2212 by 1659 pixels:
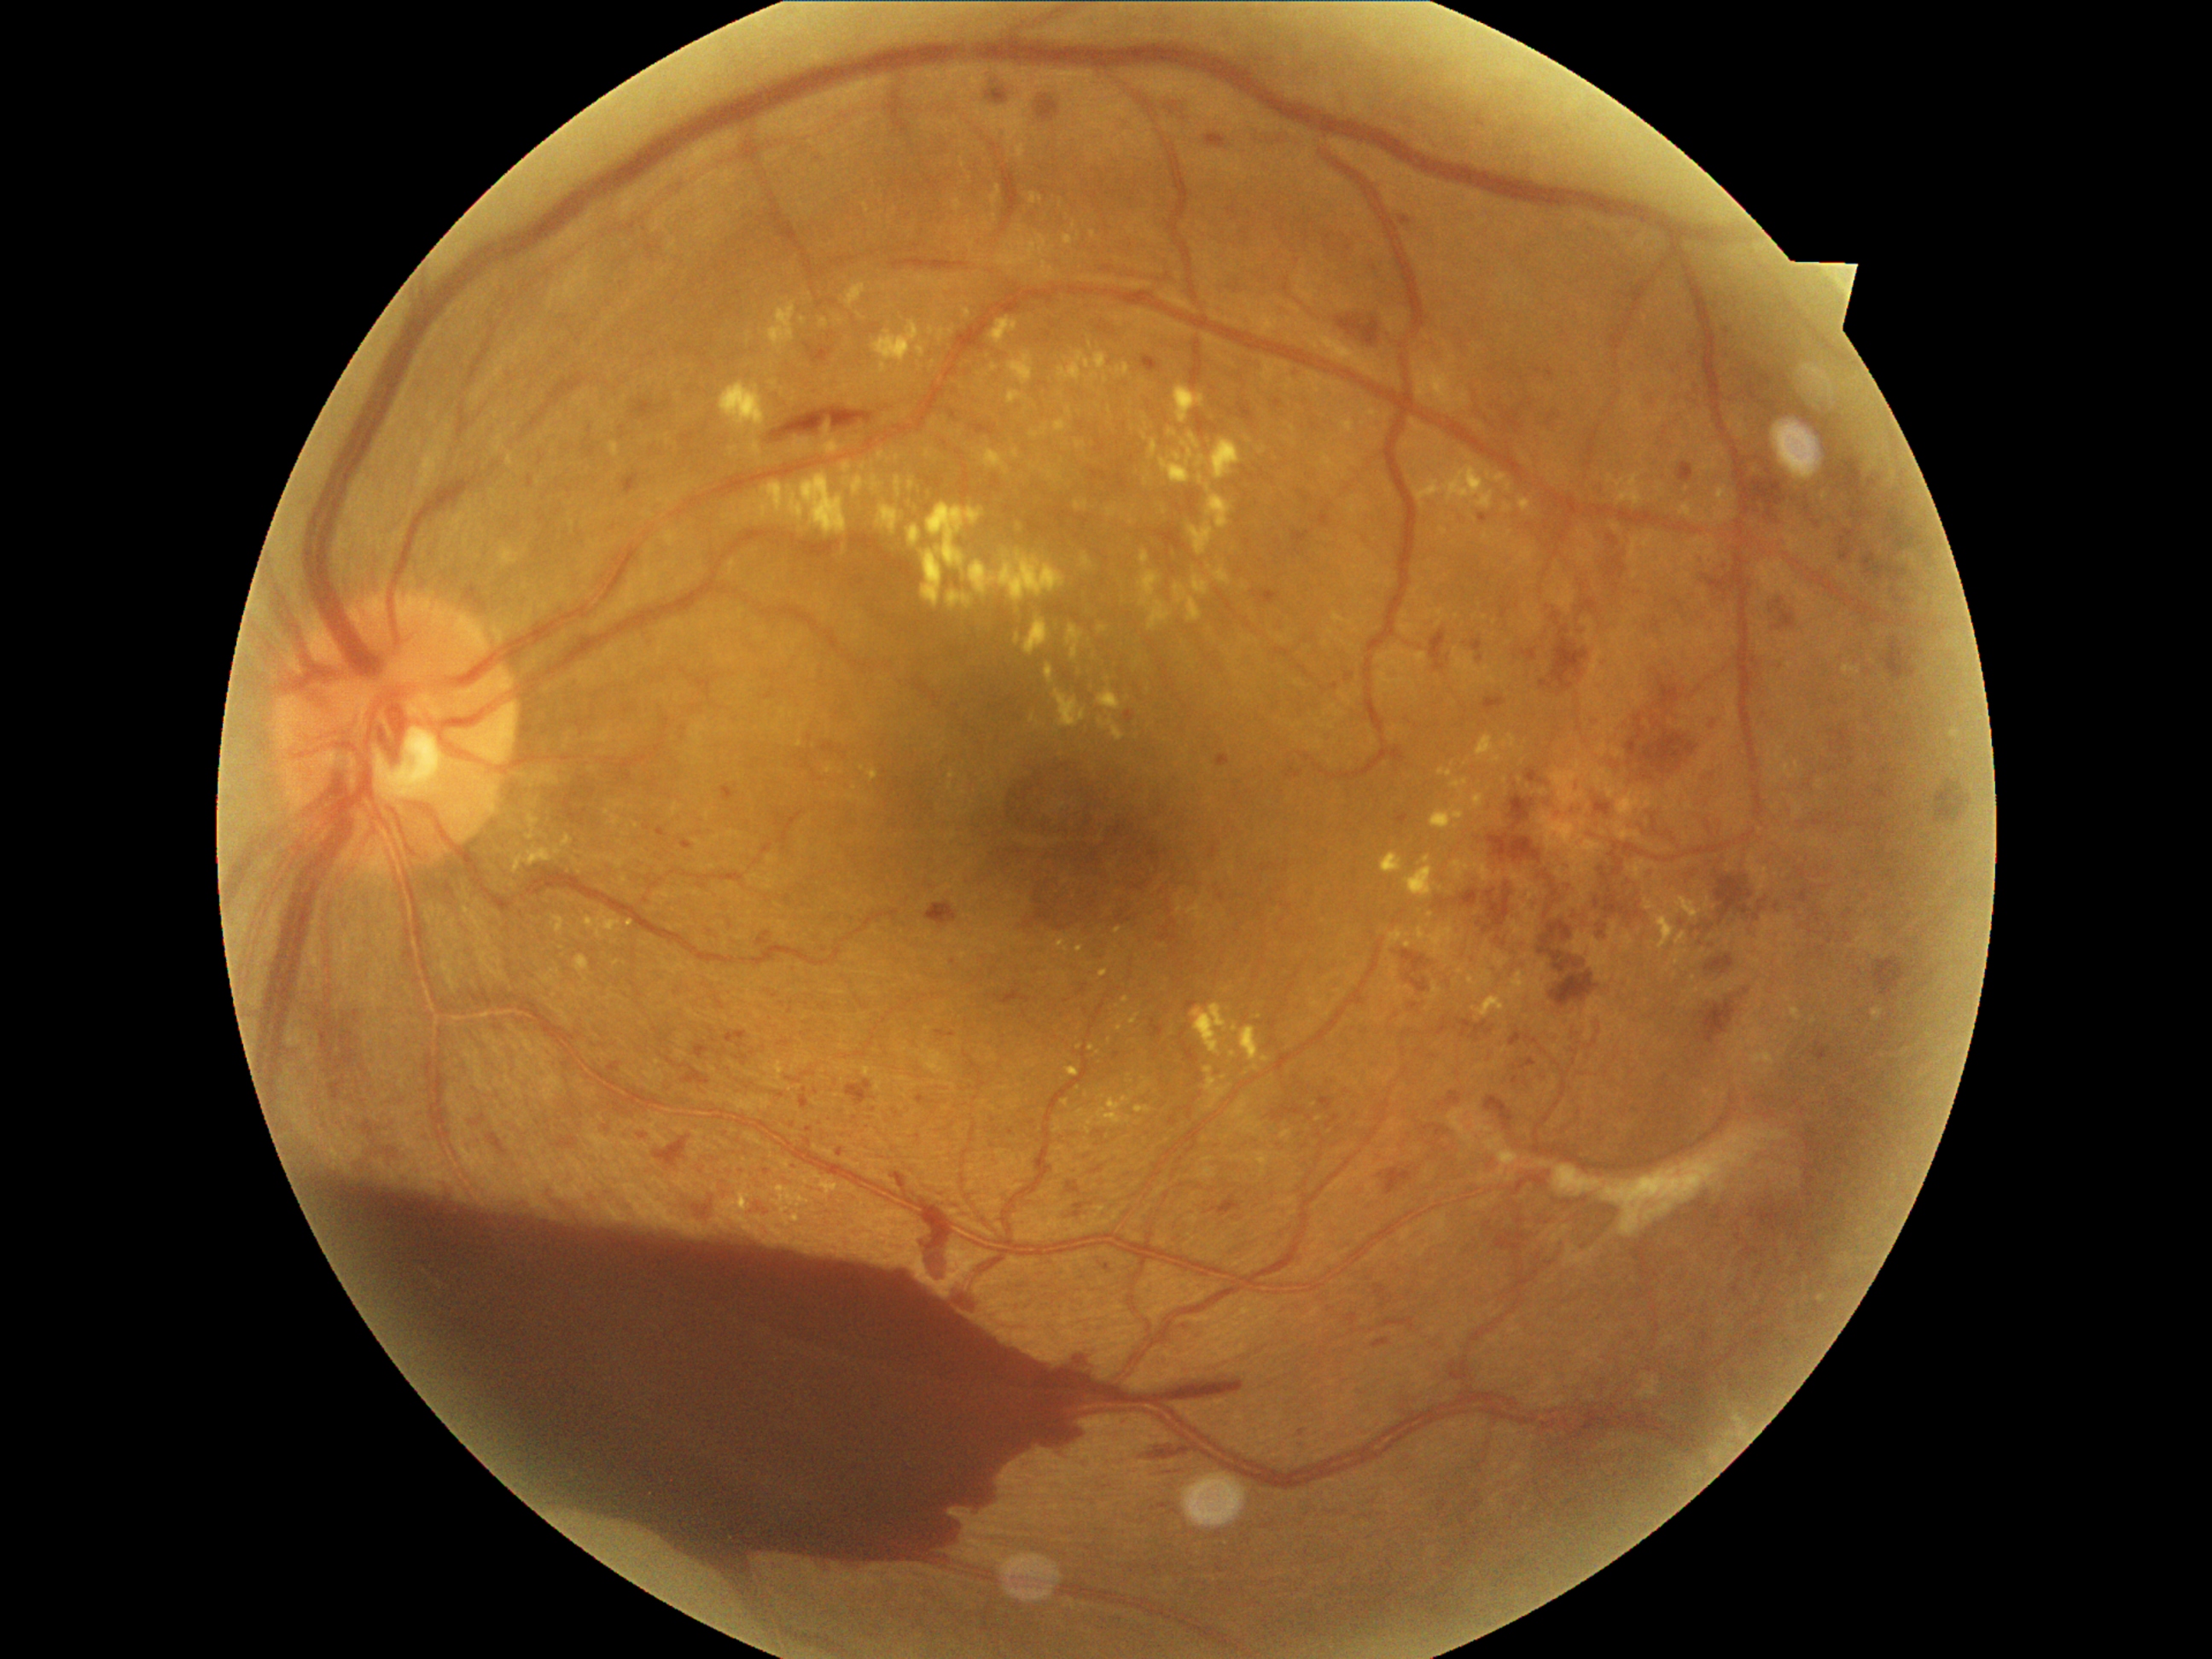

{"partial": true, "dr_grade": 4, "dr_grade_name": "PDR", "lesions": {"ex": [[1474, 795, 1484, 808], [1045, 665, 1054, 685], [1141, 550, 1150, 564], [574, 955, 590, 986], [665, 532, 678, 547], [1404, 856, 1443, 900], [1066, 407, 1073, 419], [1144, 477, 1148, 487], [1231, 1023, 1238, 1033], [1388, 931, 1406, 948], [1658, 484, 1665, 498], [1416, 453, 1511, 509], [1206, 1066, 1231, 1110], [813, 1172, 839, 1201]], "ex_small": [[962, 386], [1487, 536], [1247, 440], [862, 318], [1110, 410]], "ma": [[1252, 591, 1279, 605], [1607, 535, 1619, 545], [1274, 400, 1283, 409], [1185, 1001, 1197, 1010], [1831, 742, 1836, 750], [805, 344, 834, 364], [1522, 649, 1539, 661], [726, 1032, 747, 1044], [716, 998, 726, 1011], [1477, 515, 1487, 523], [1525, 769, 1544, 784], [1378, 1168, 1412, 1196], [1597, 803, 1610, 815], [837, 1148, 844, 1156], [554, 1136, 579, 1153]], "ma_small": [[1335, 687], [1816, 525], [1851, 761], [1894, 591], [808, 1142]]}}